1240x1240px; wide-field fundus photograph of an infant; captured with the Phoenix ICON (100° field of view) — 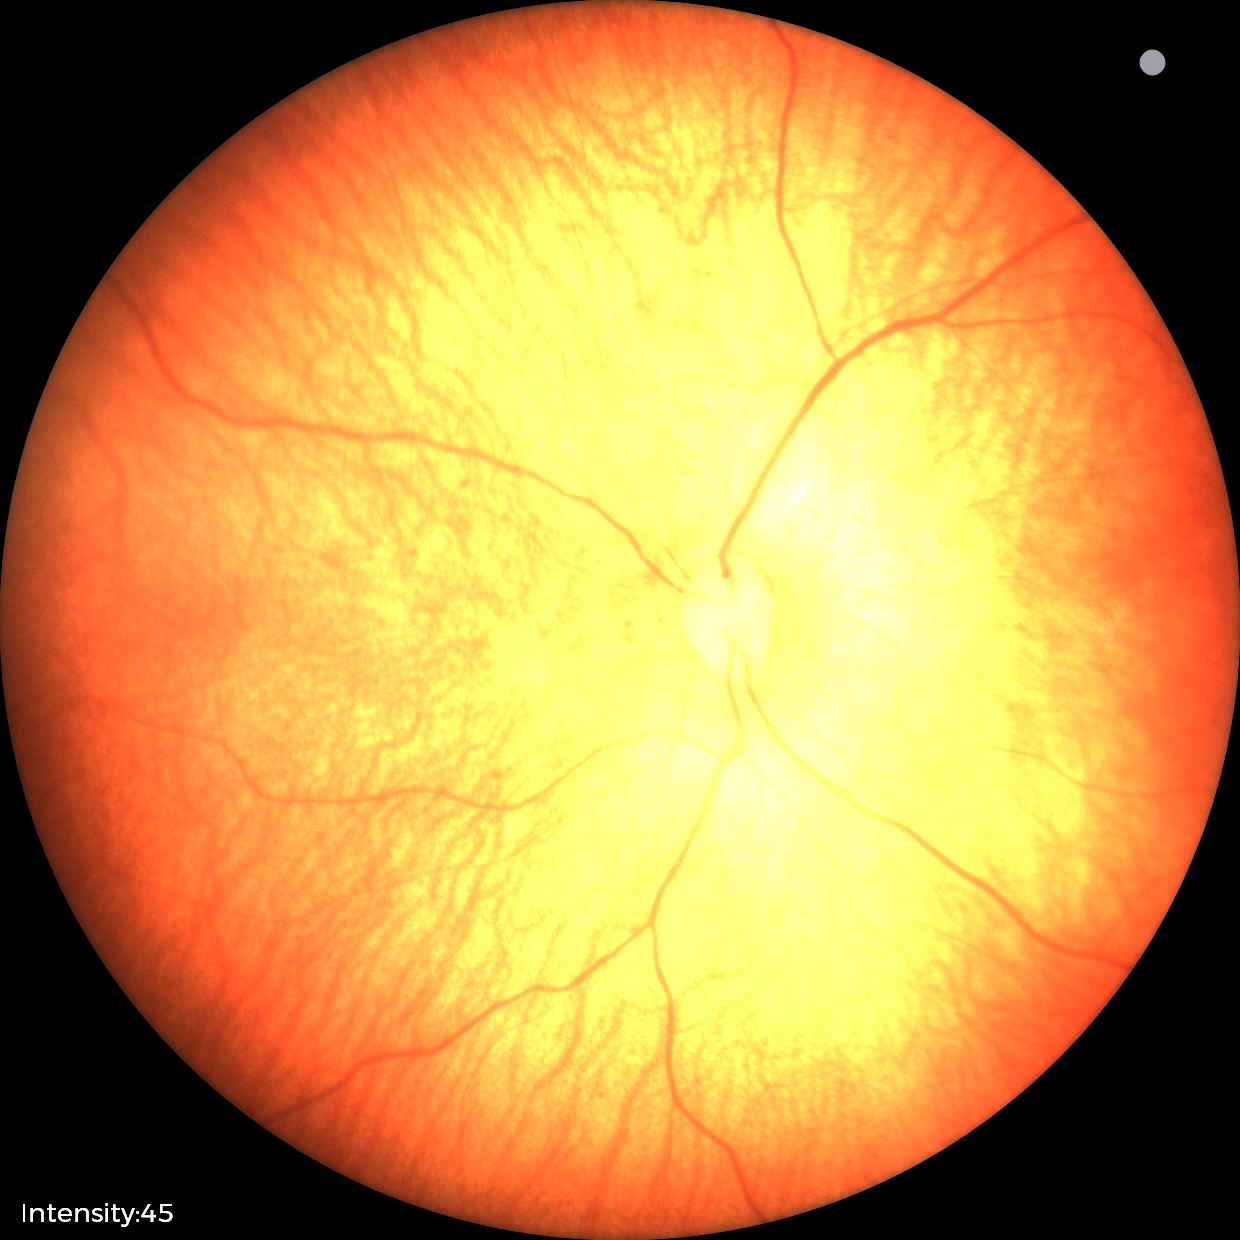
Q: What is the screening diagnosis?
A: physiological finding